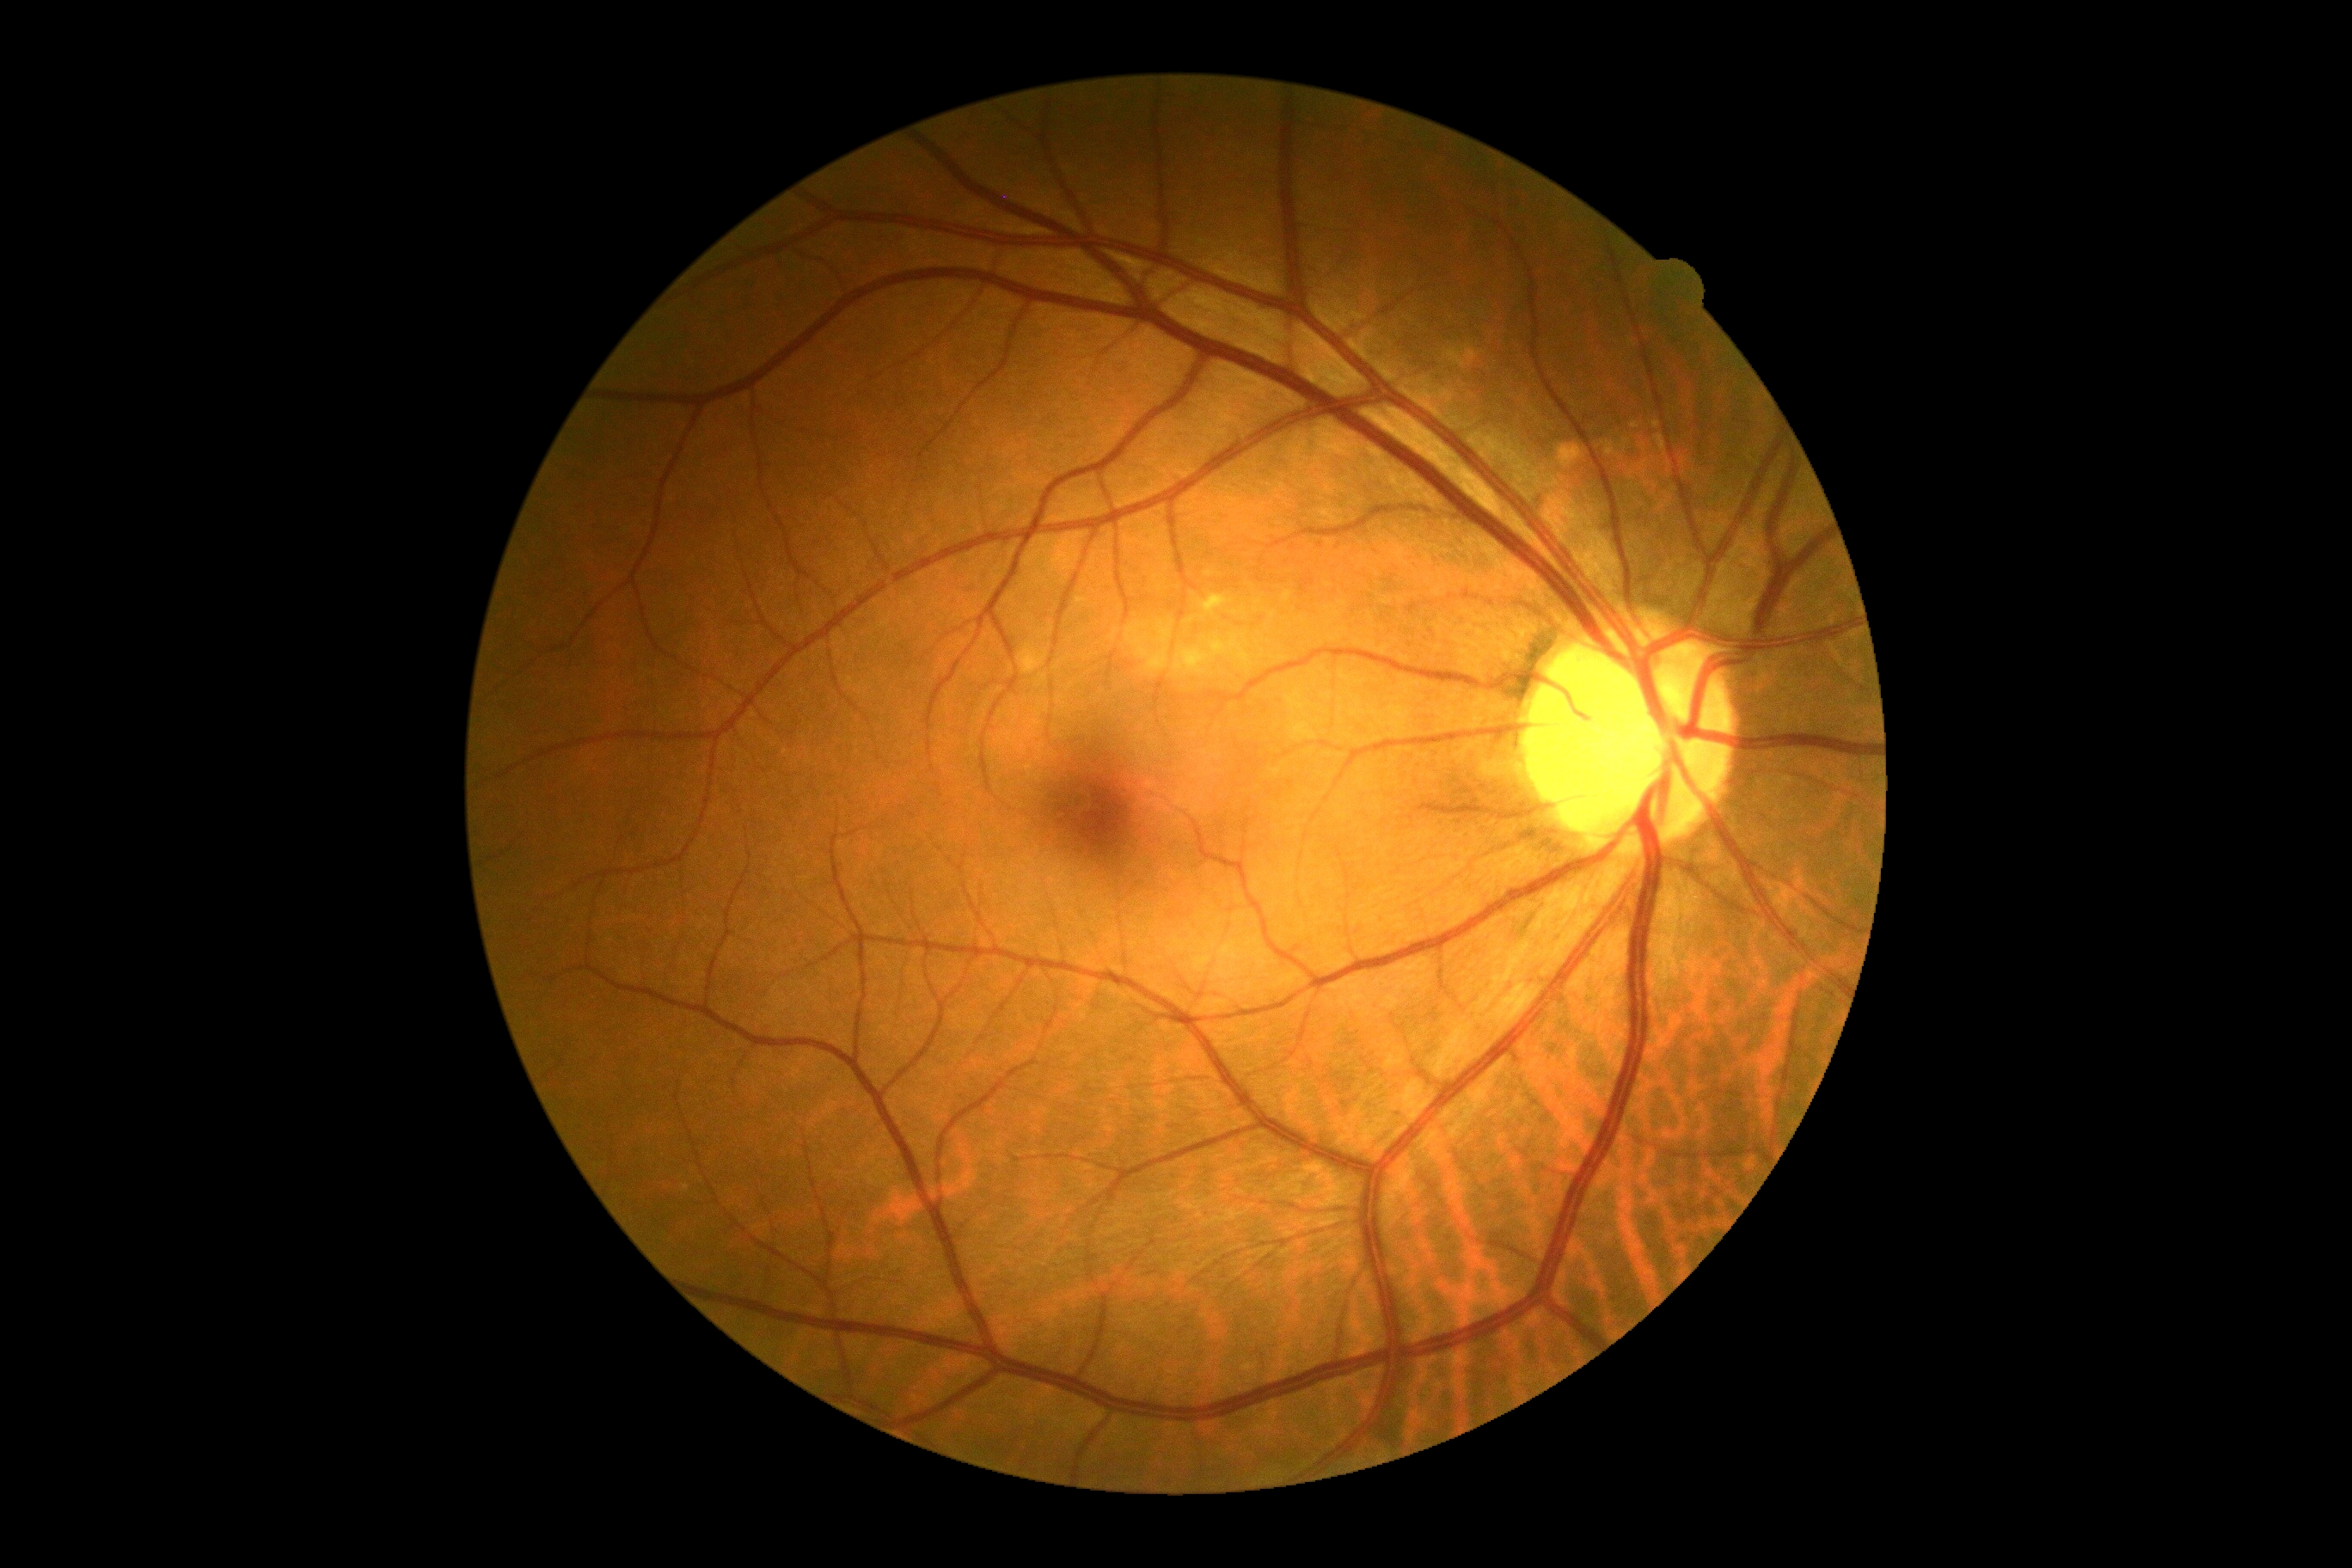 Diabetic retinopathy: 0.